CFP.
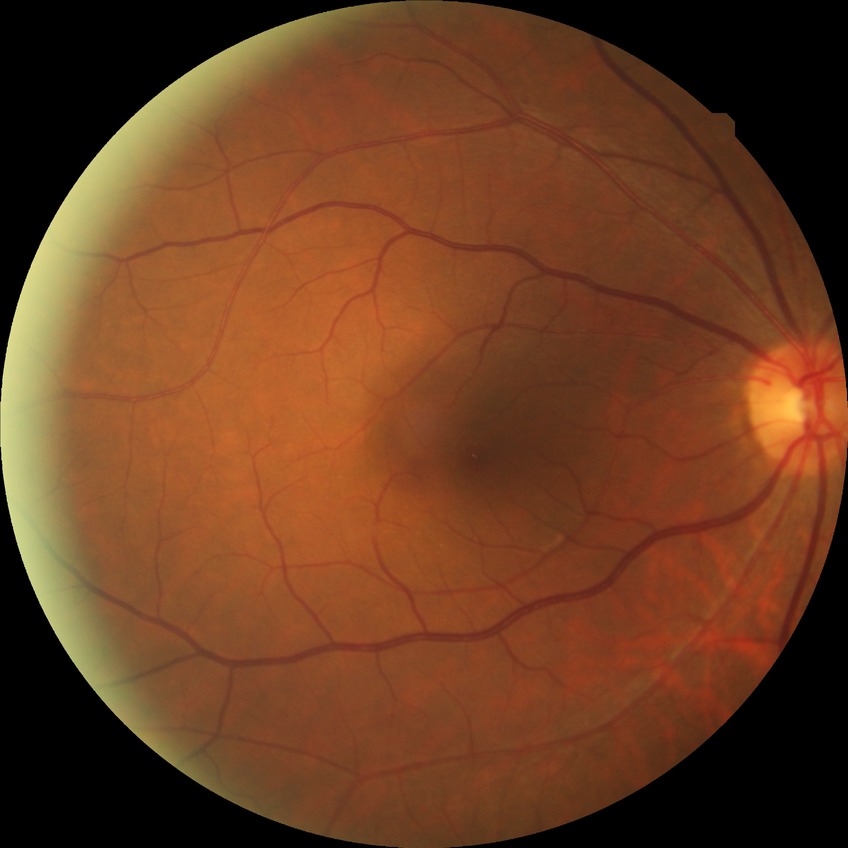 Diabetic retinopathy (DR): NDR (no diabetic retinopathy).